Modified Davis classification. Color fundus photograph:
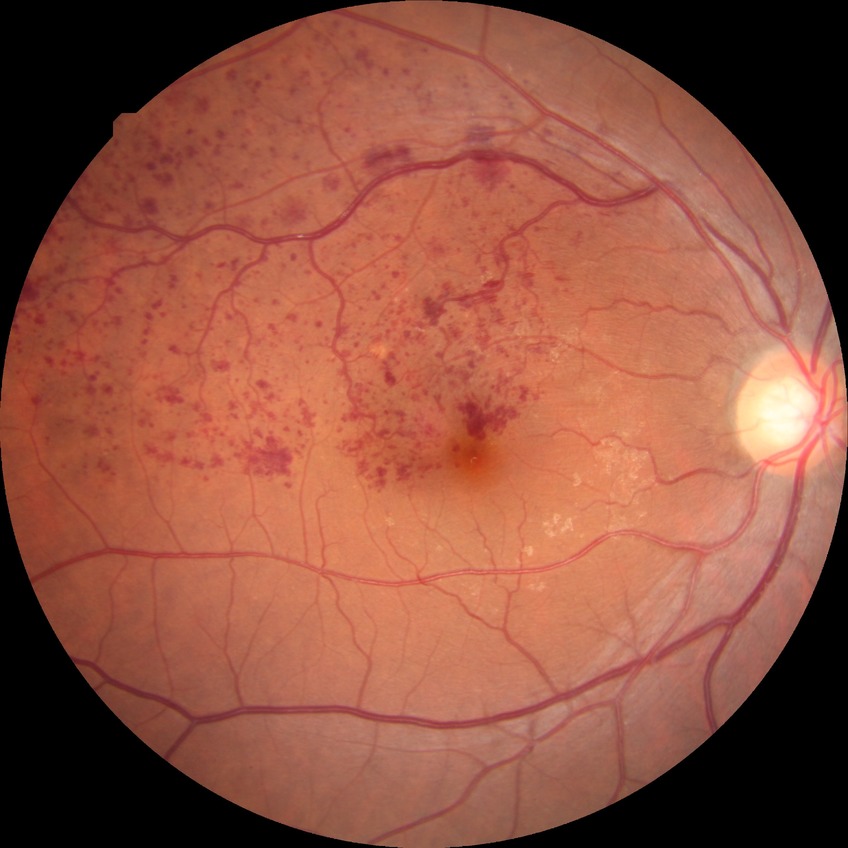

DR stage: NDR.
No apparent diabetic retinopathy.